1240x1240px · camera: Phoenix ICON (100° FOV) · infant wide-field fundus photograph: 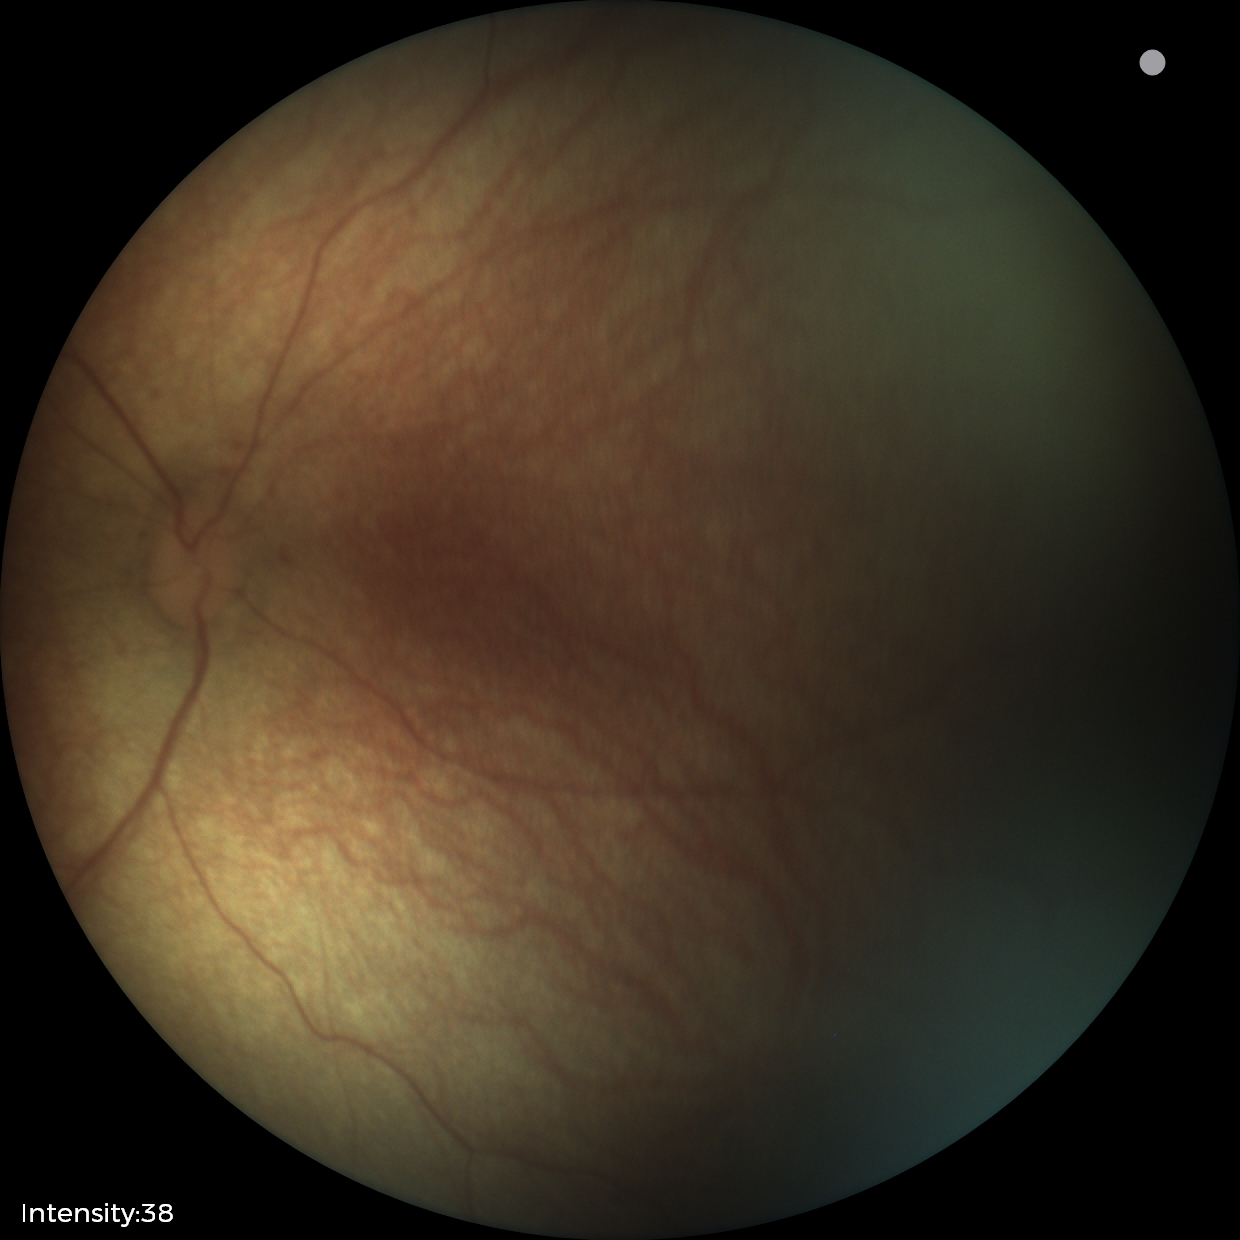 Screening examination with no abnormal retinal findings.